Pediatric retinal photograph (wide-field) · acquired on the Clarity RetCam 3 — 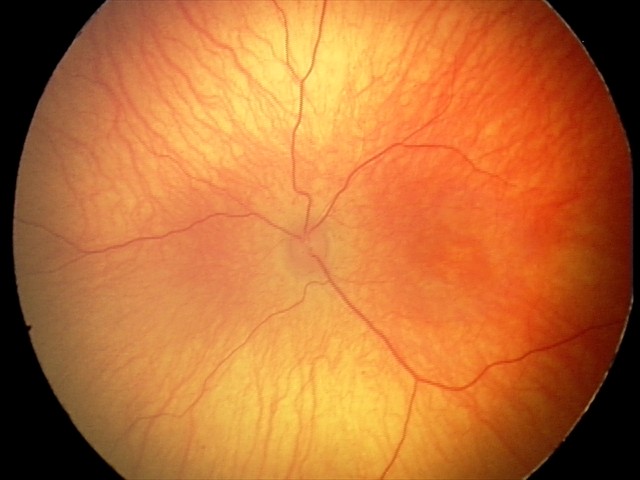

Assessment: physiological.